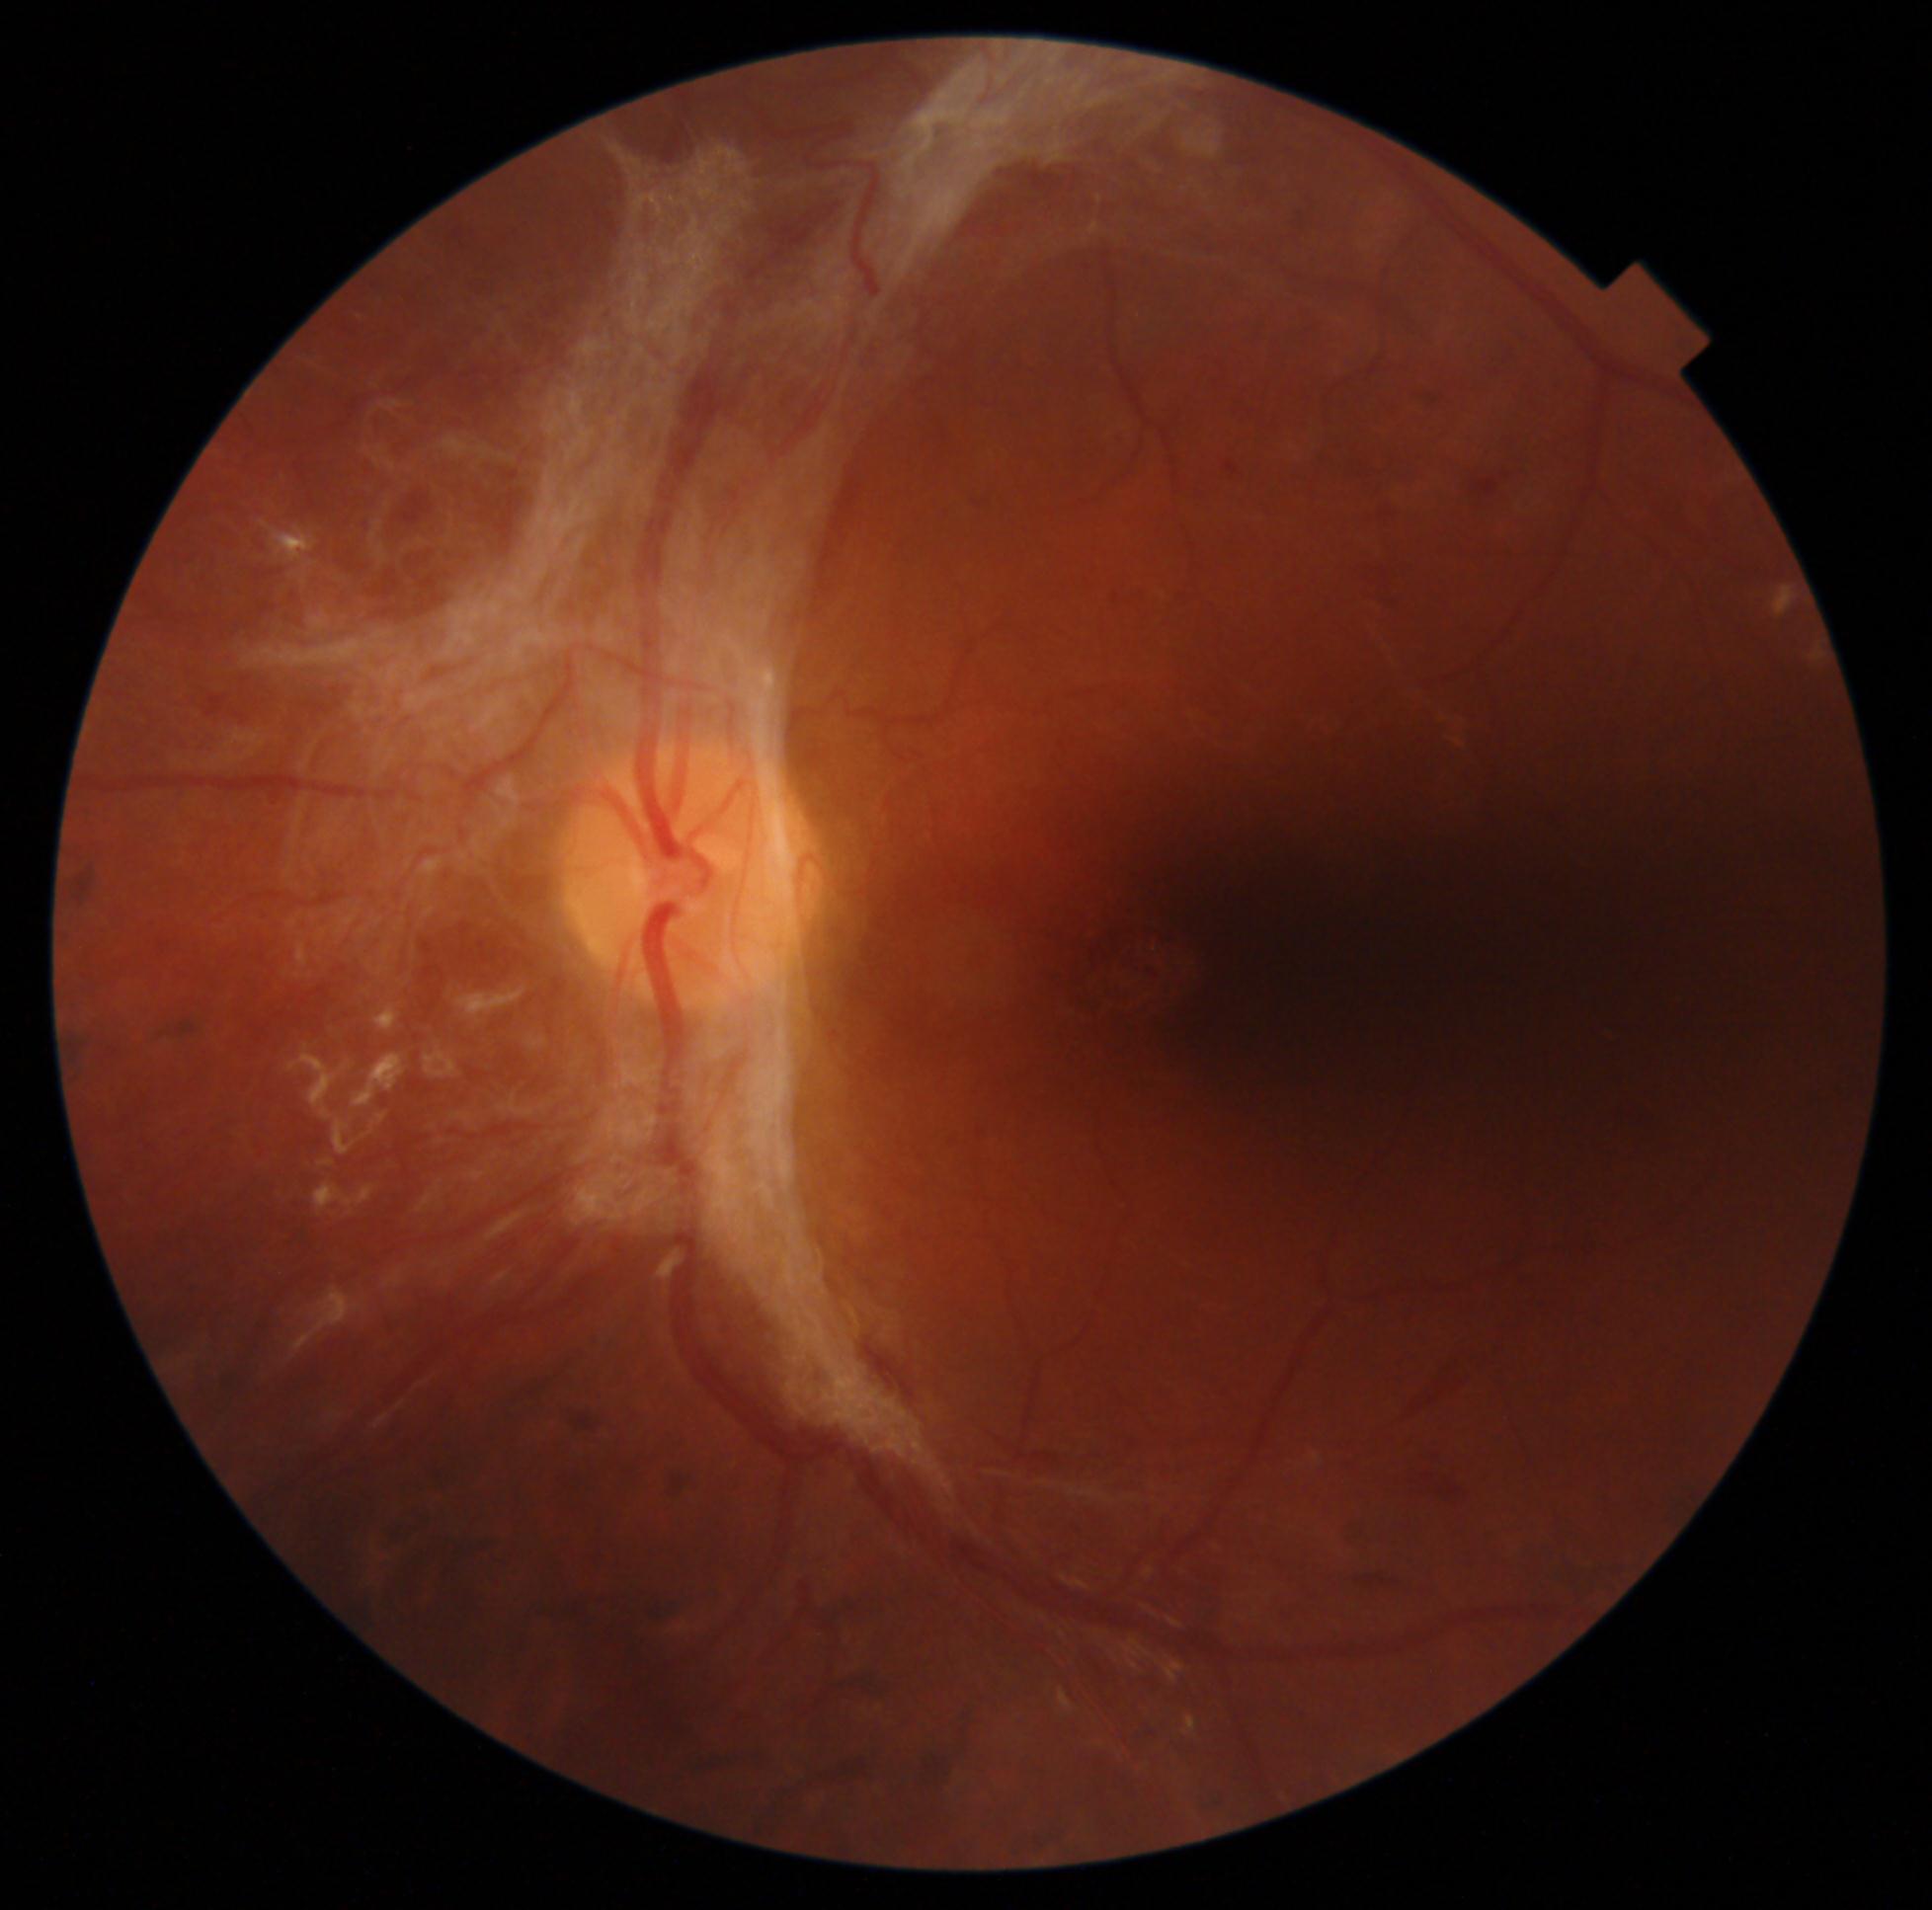

Diabetic retinopathy (DR) is grade 4 (PDR).